Pediatric retinal photograph (wide-field).
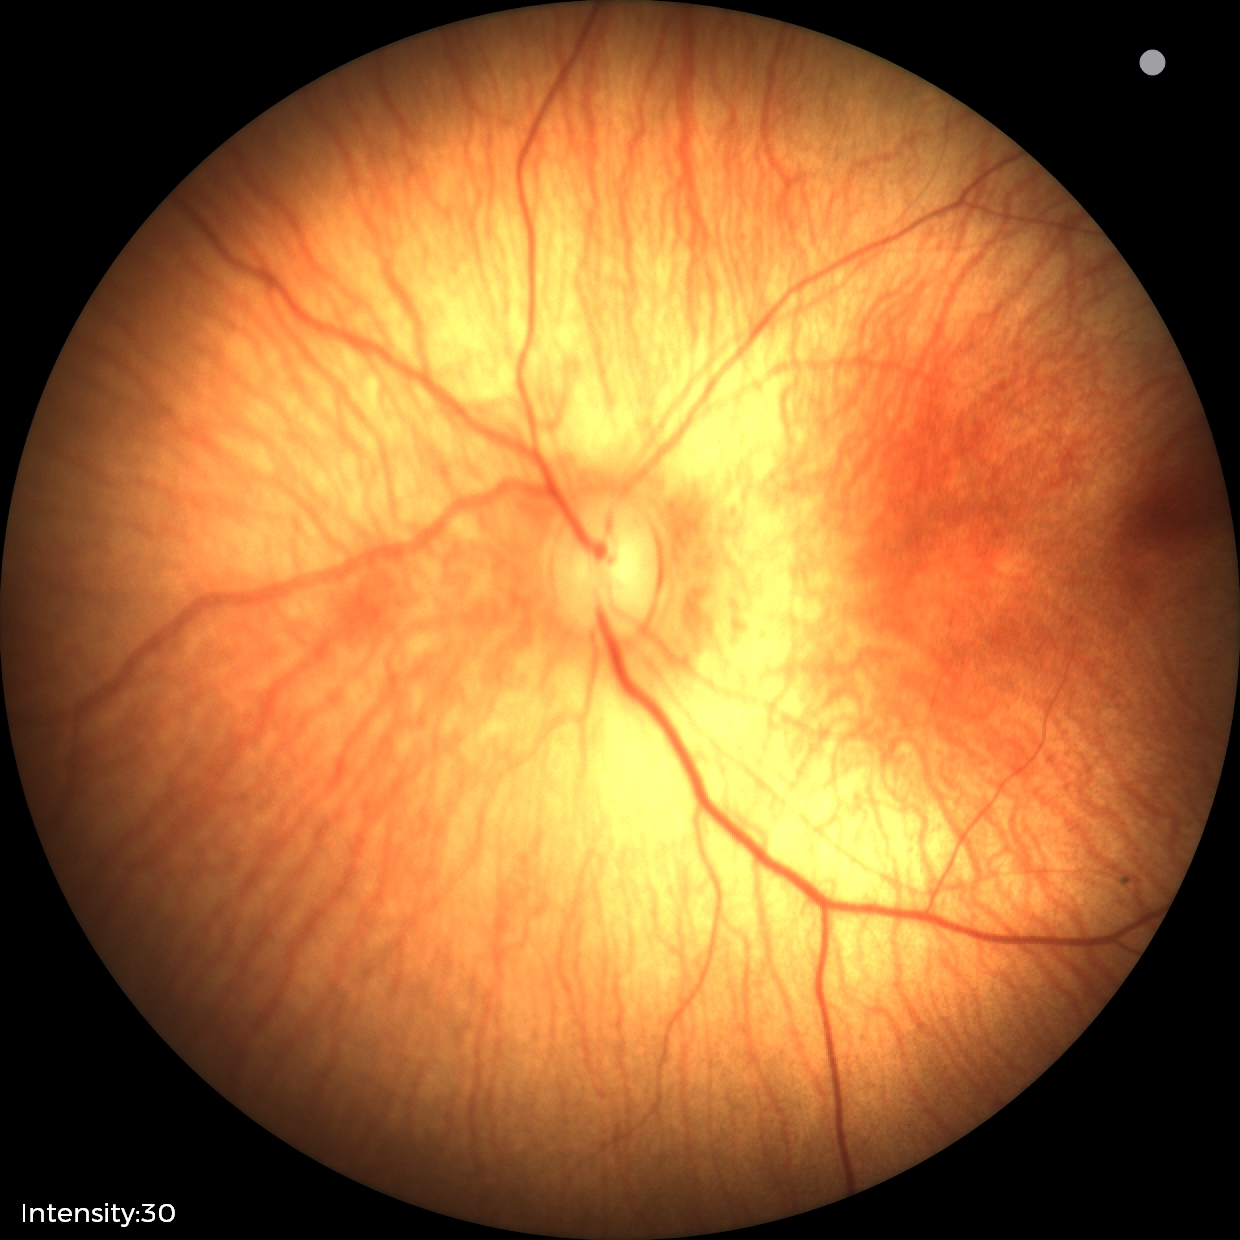
Normal screening examination.